1380 x 1382 pixels: 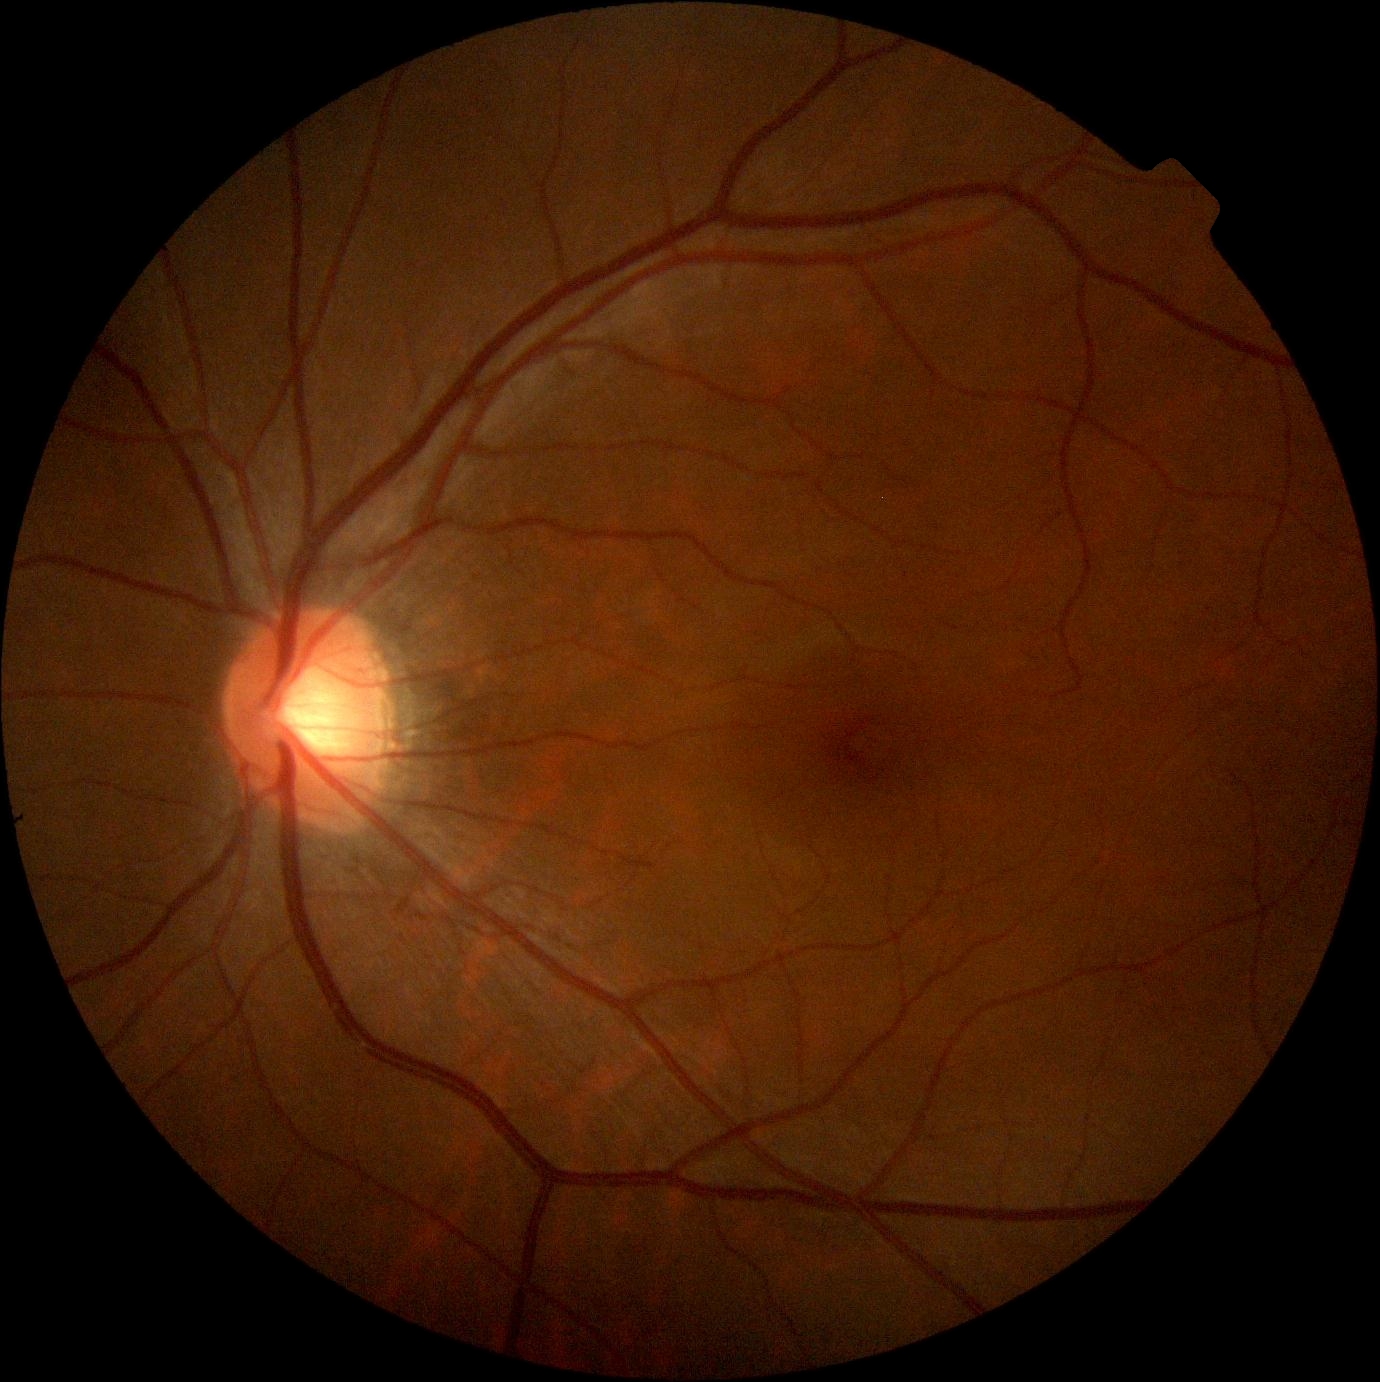 – diabetic retinopathy — grade 0 (no apparent retinopathy)